2212 by 1659 pixels, 45° field of view — 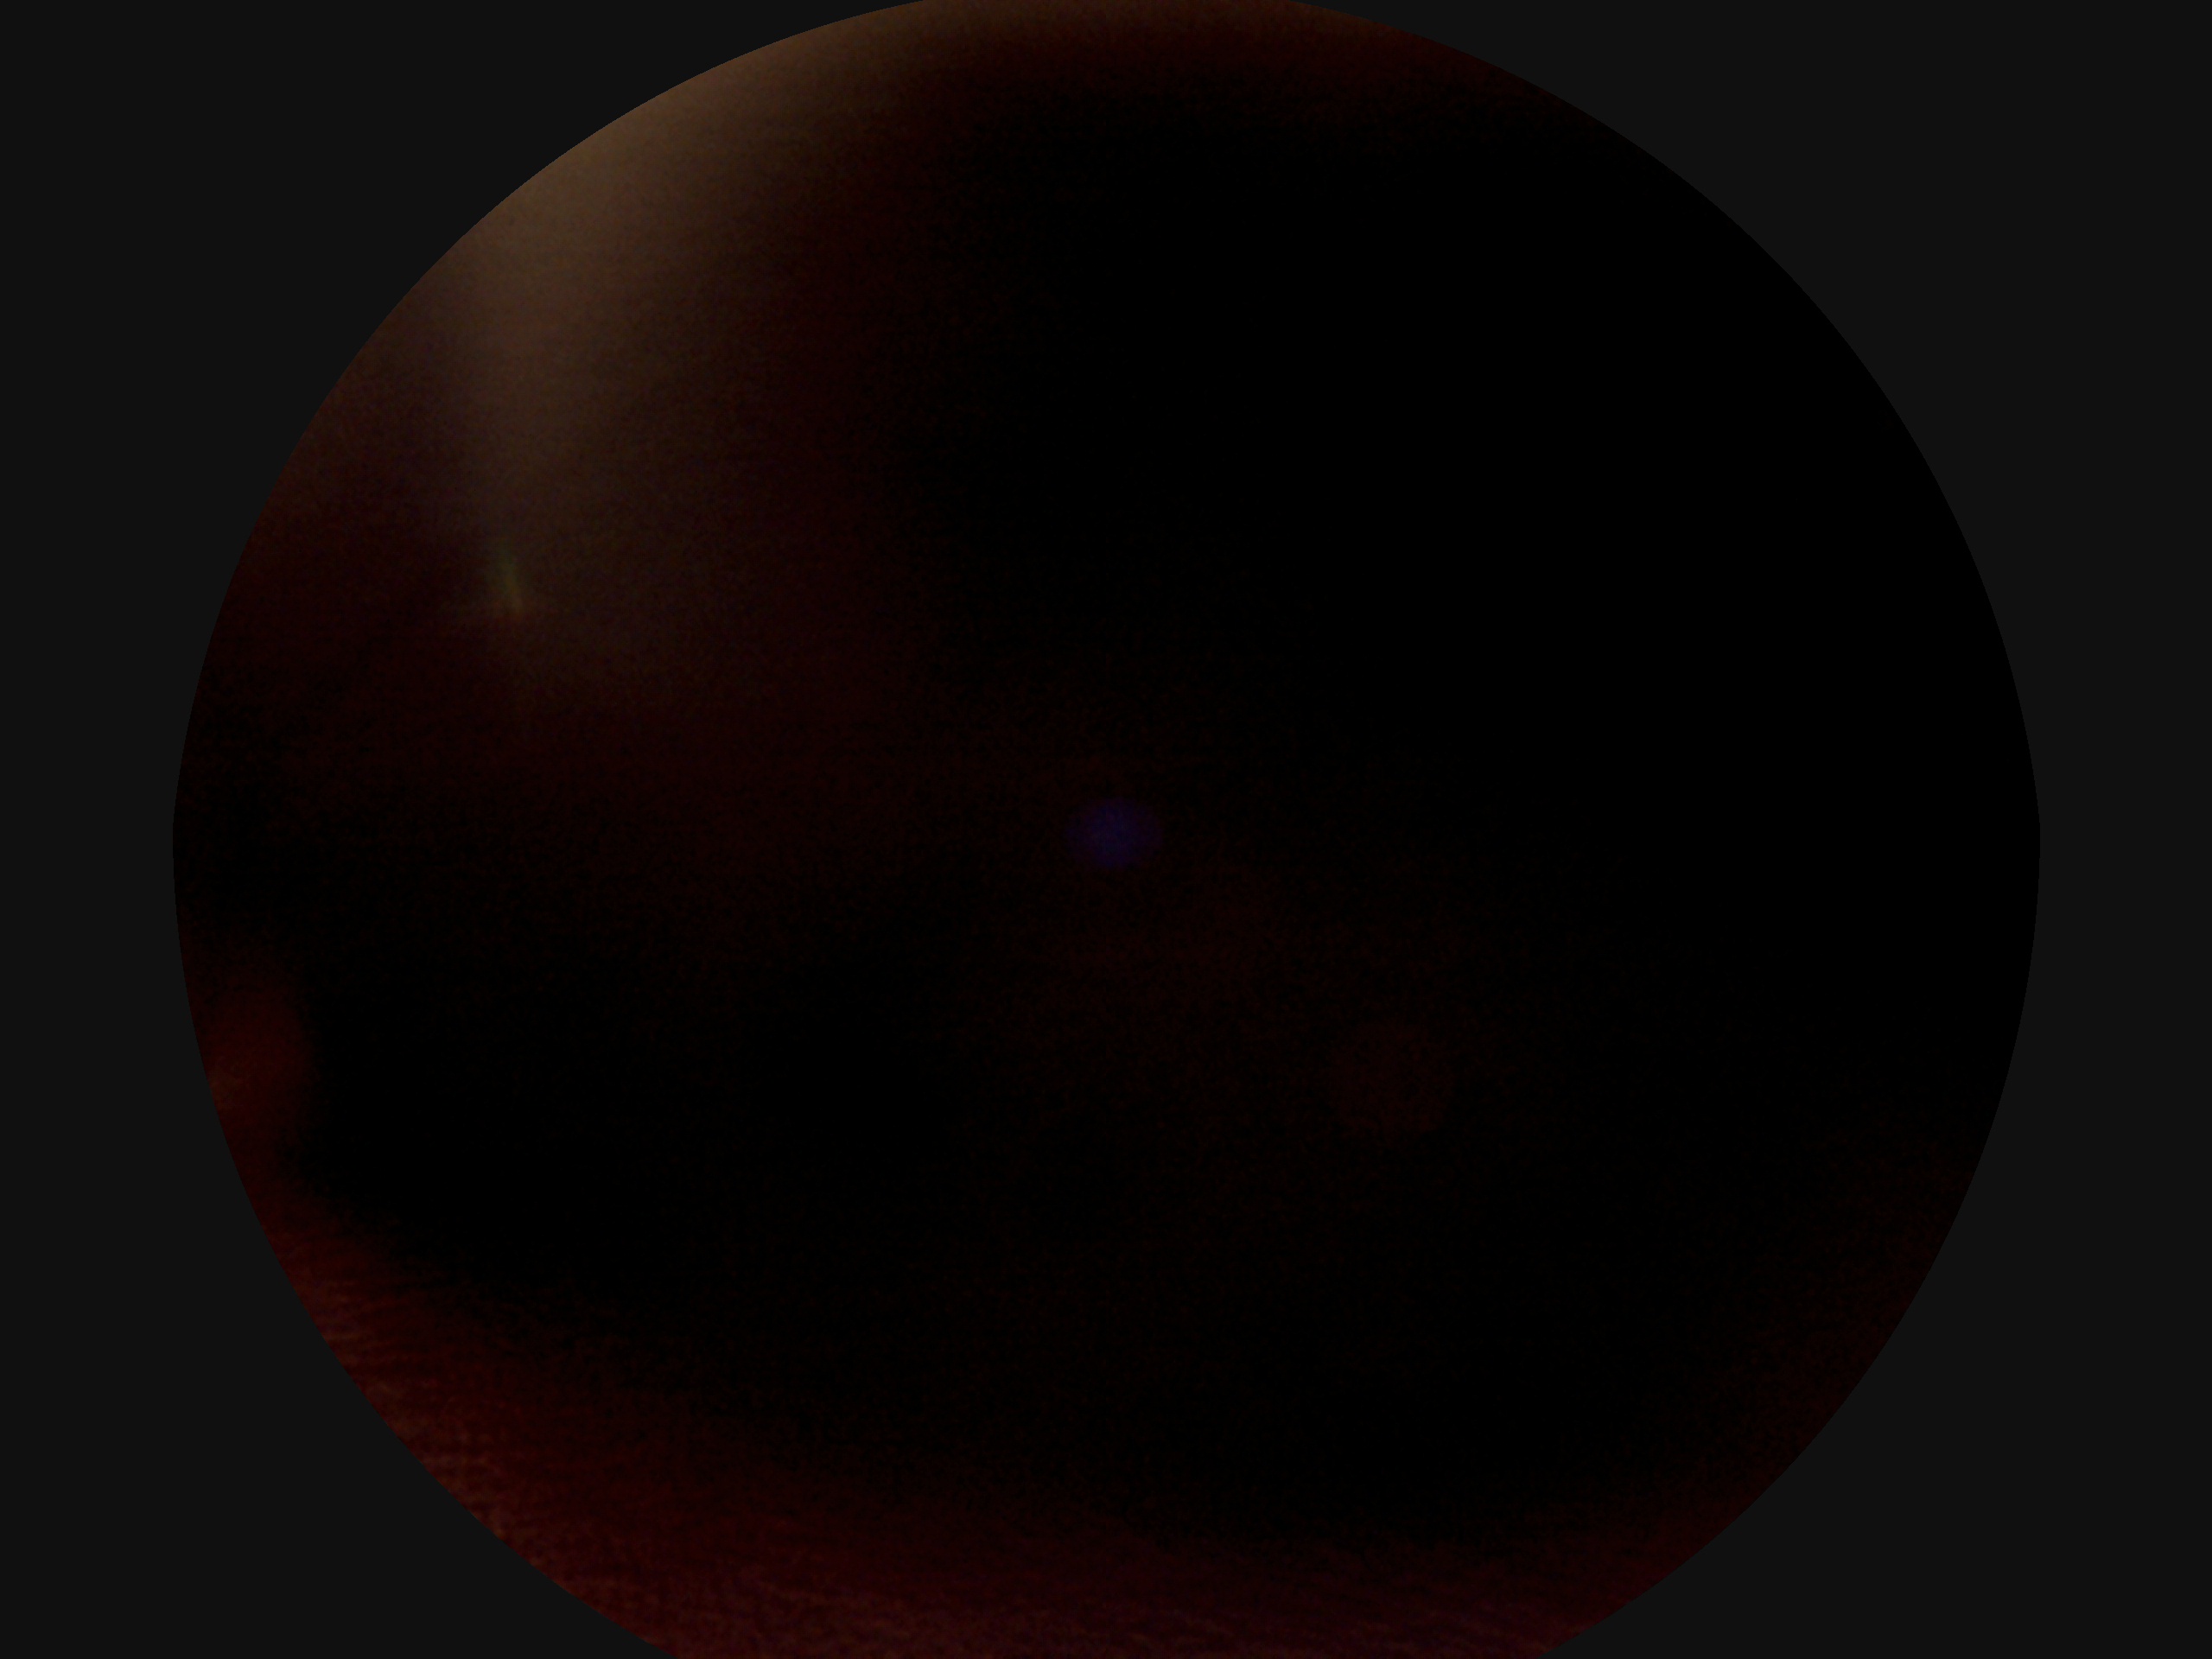

The image cannot be graded for diabetic retinopathy. DR stage: ungradable.